Modified Davis classification: 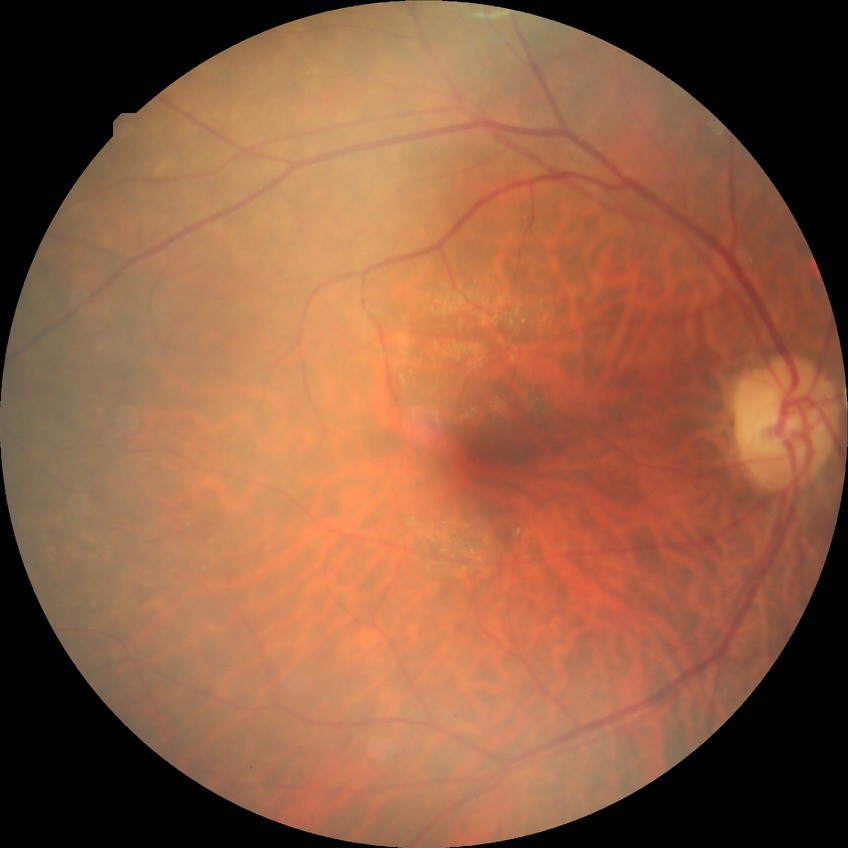

diabetic retinopathy grade: no diabetic retinopathy.